Wide-field fundus photograph of an infant · Clarity RetCam 3, 130° FOV — 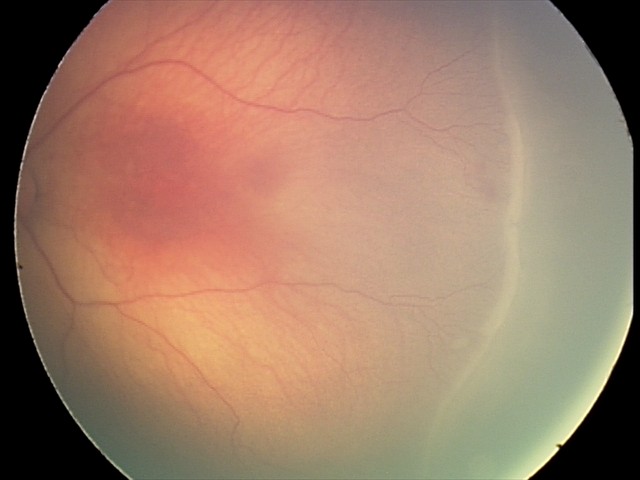

Assessment: no plus disease; retinopathy of prematurity (ROP) stage 2 — ridge with height and width at the demarcation line.